Fundus photo; 412 by 310 pixels — 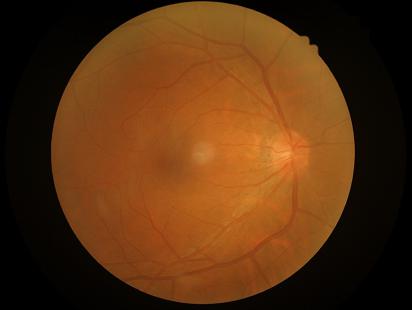
Image quality is adequate for diagnostic use.
Image is sharp throughout the field.
No over- or under-exposure.